Infant wide-field fundus photograph: 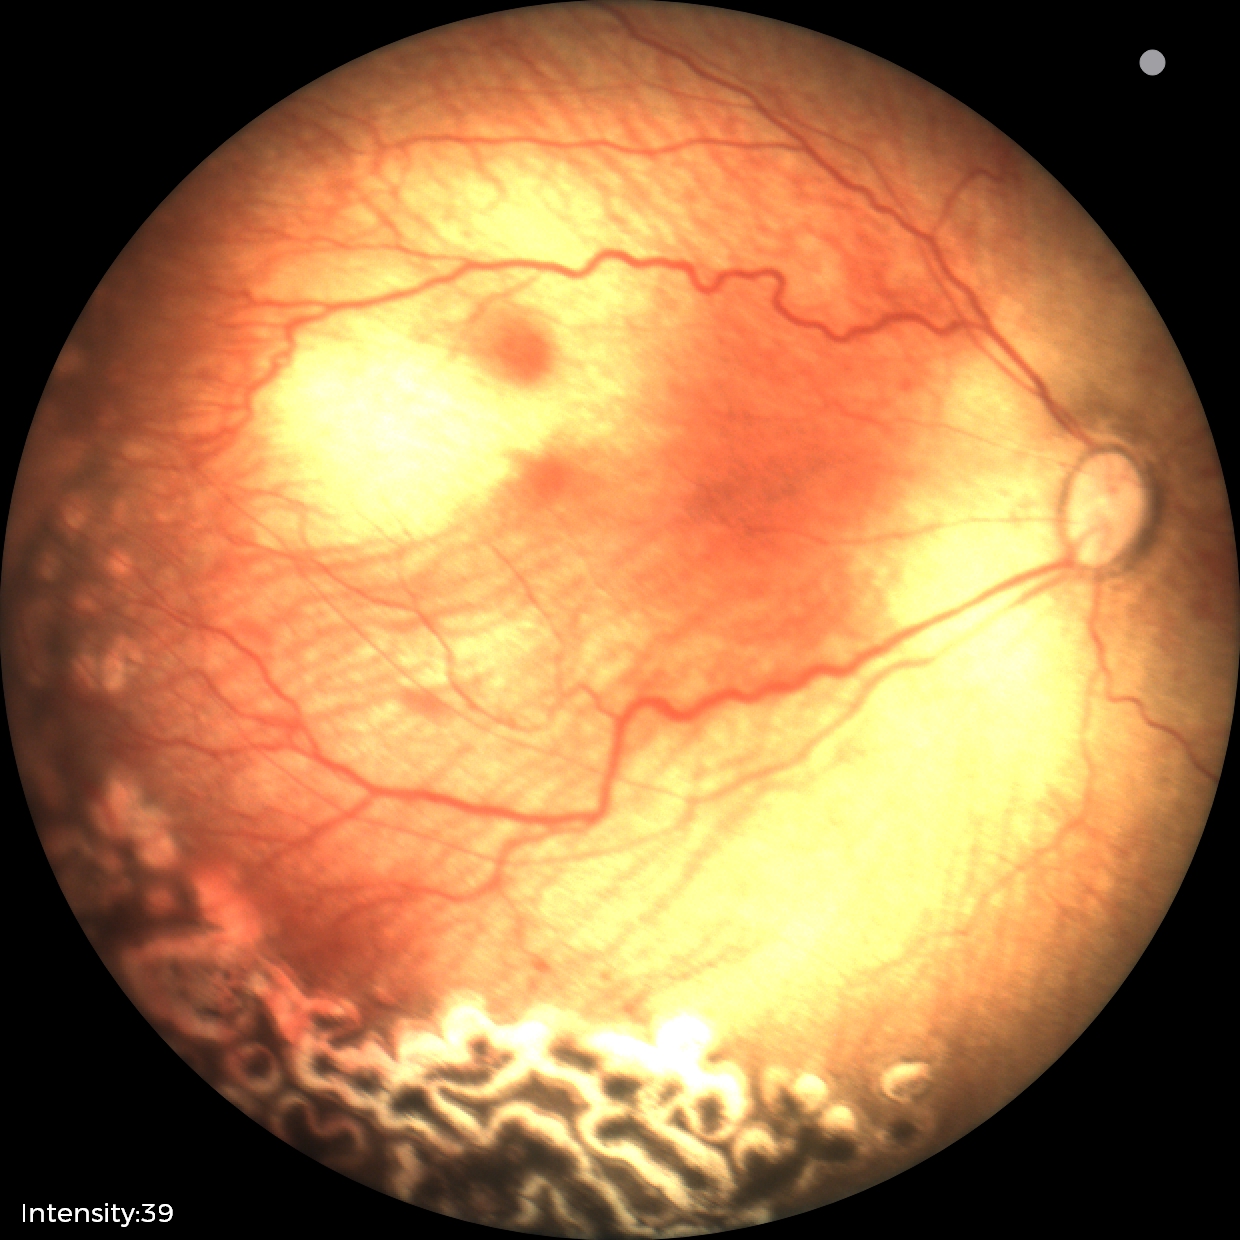
Screening: status post retinopathy of prematurity; no plus disease — posterior pole vessels without abnormal dilation or tortuosity.